45° FOV. Color fundus photograph: 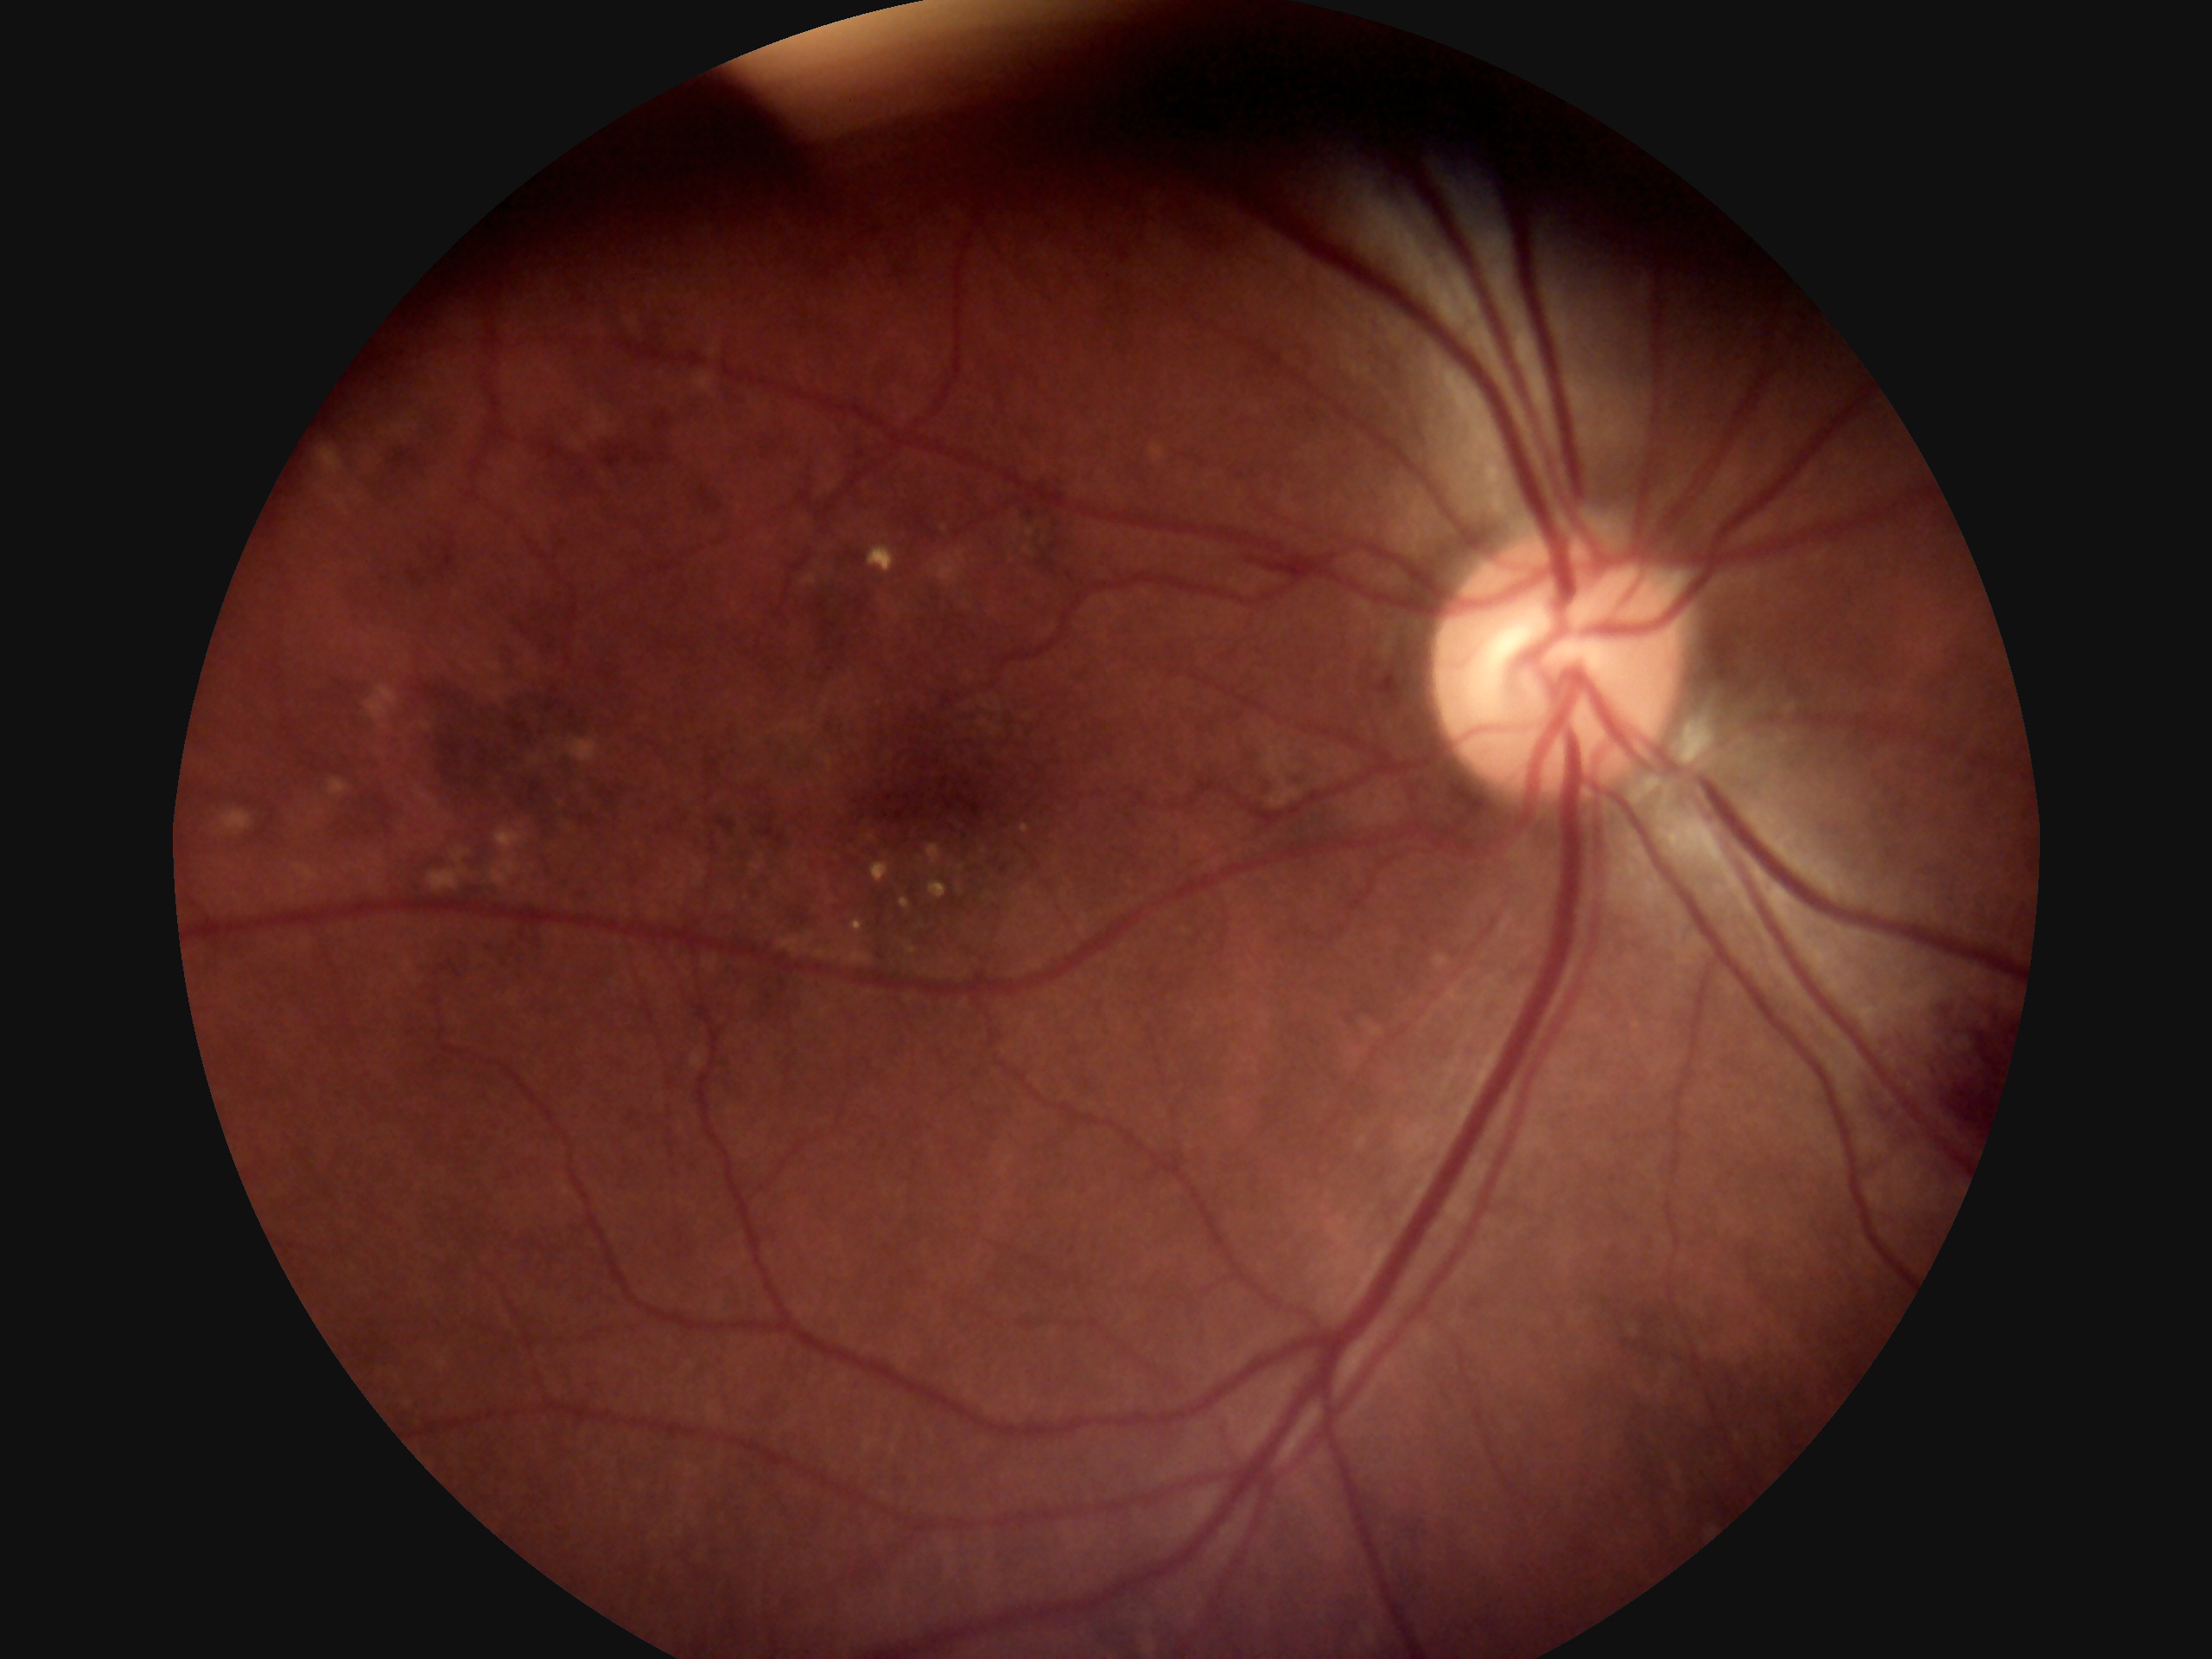 diabetic retinopathy=2.